Captured with the Phoenix ICON (100° field of view) · pediatric wide-field fundus photograph — 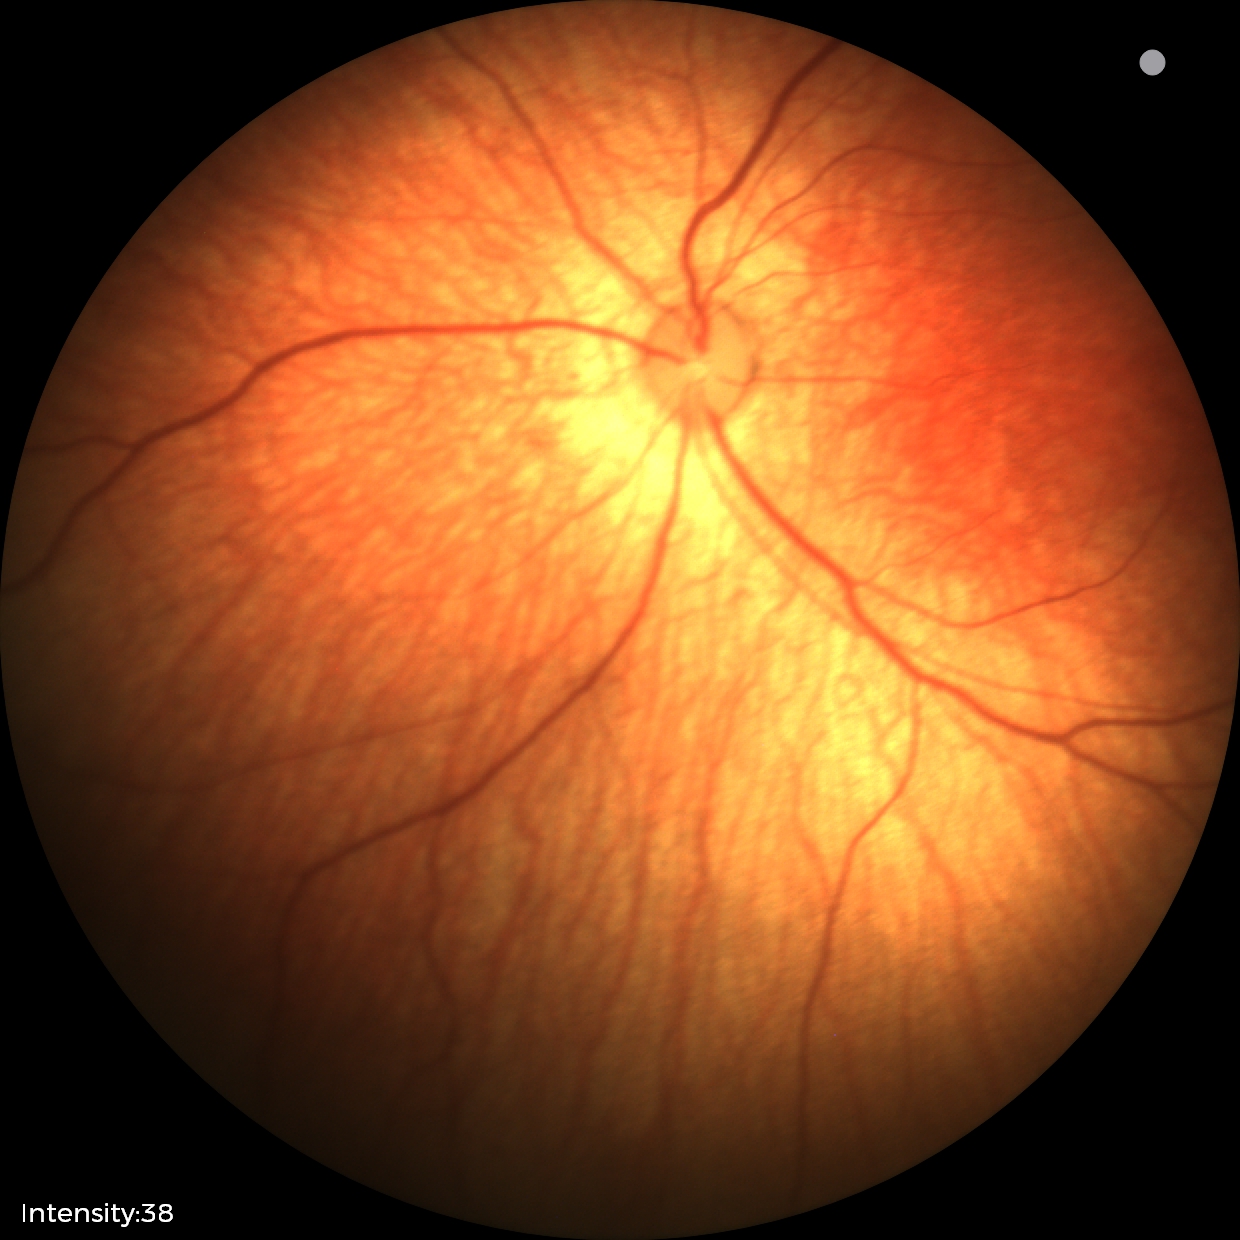

Impression: no abnormal retinal findings.